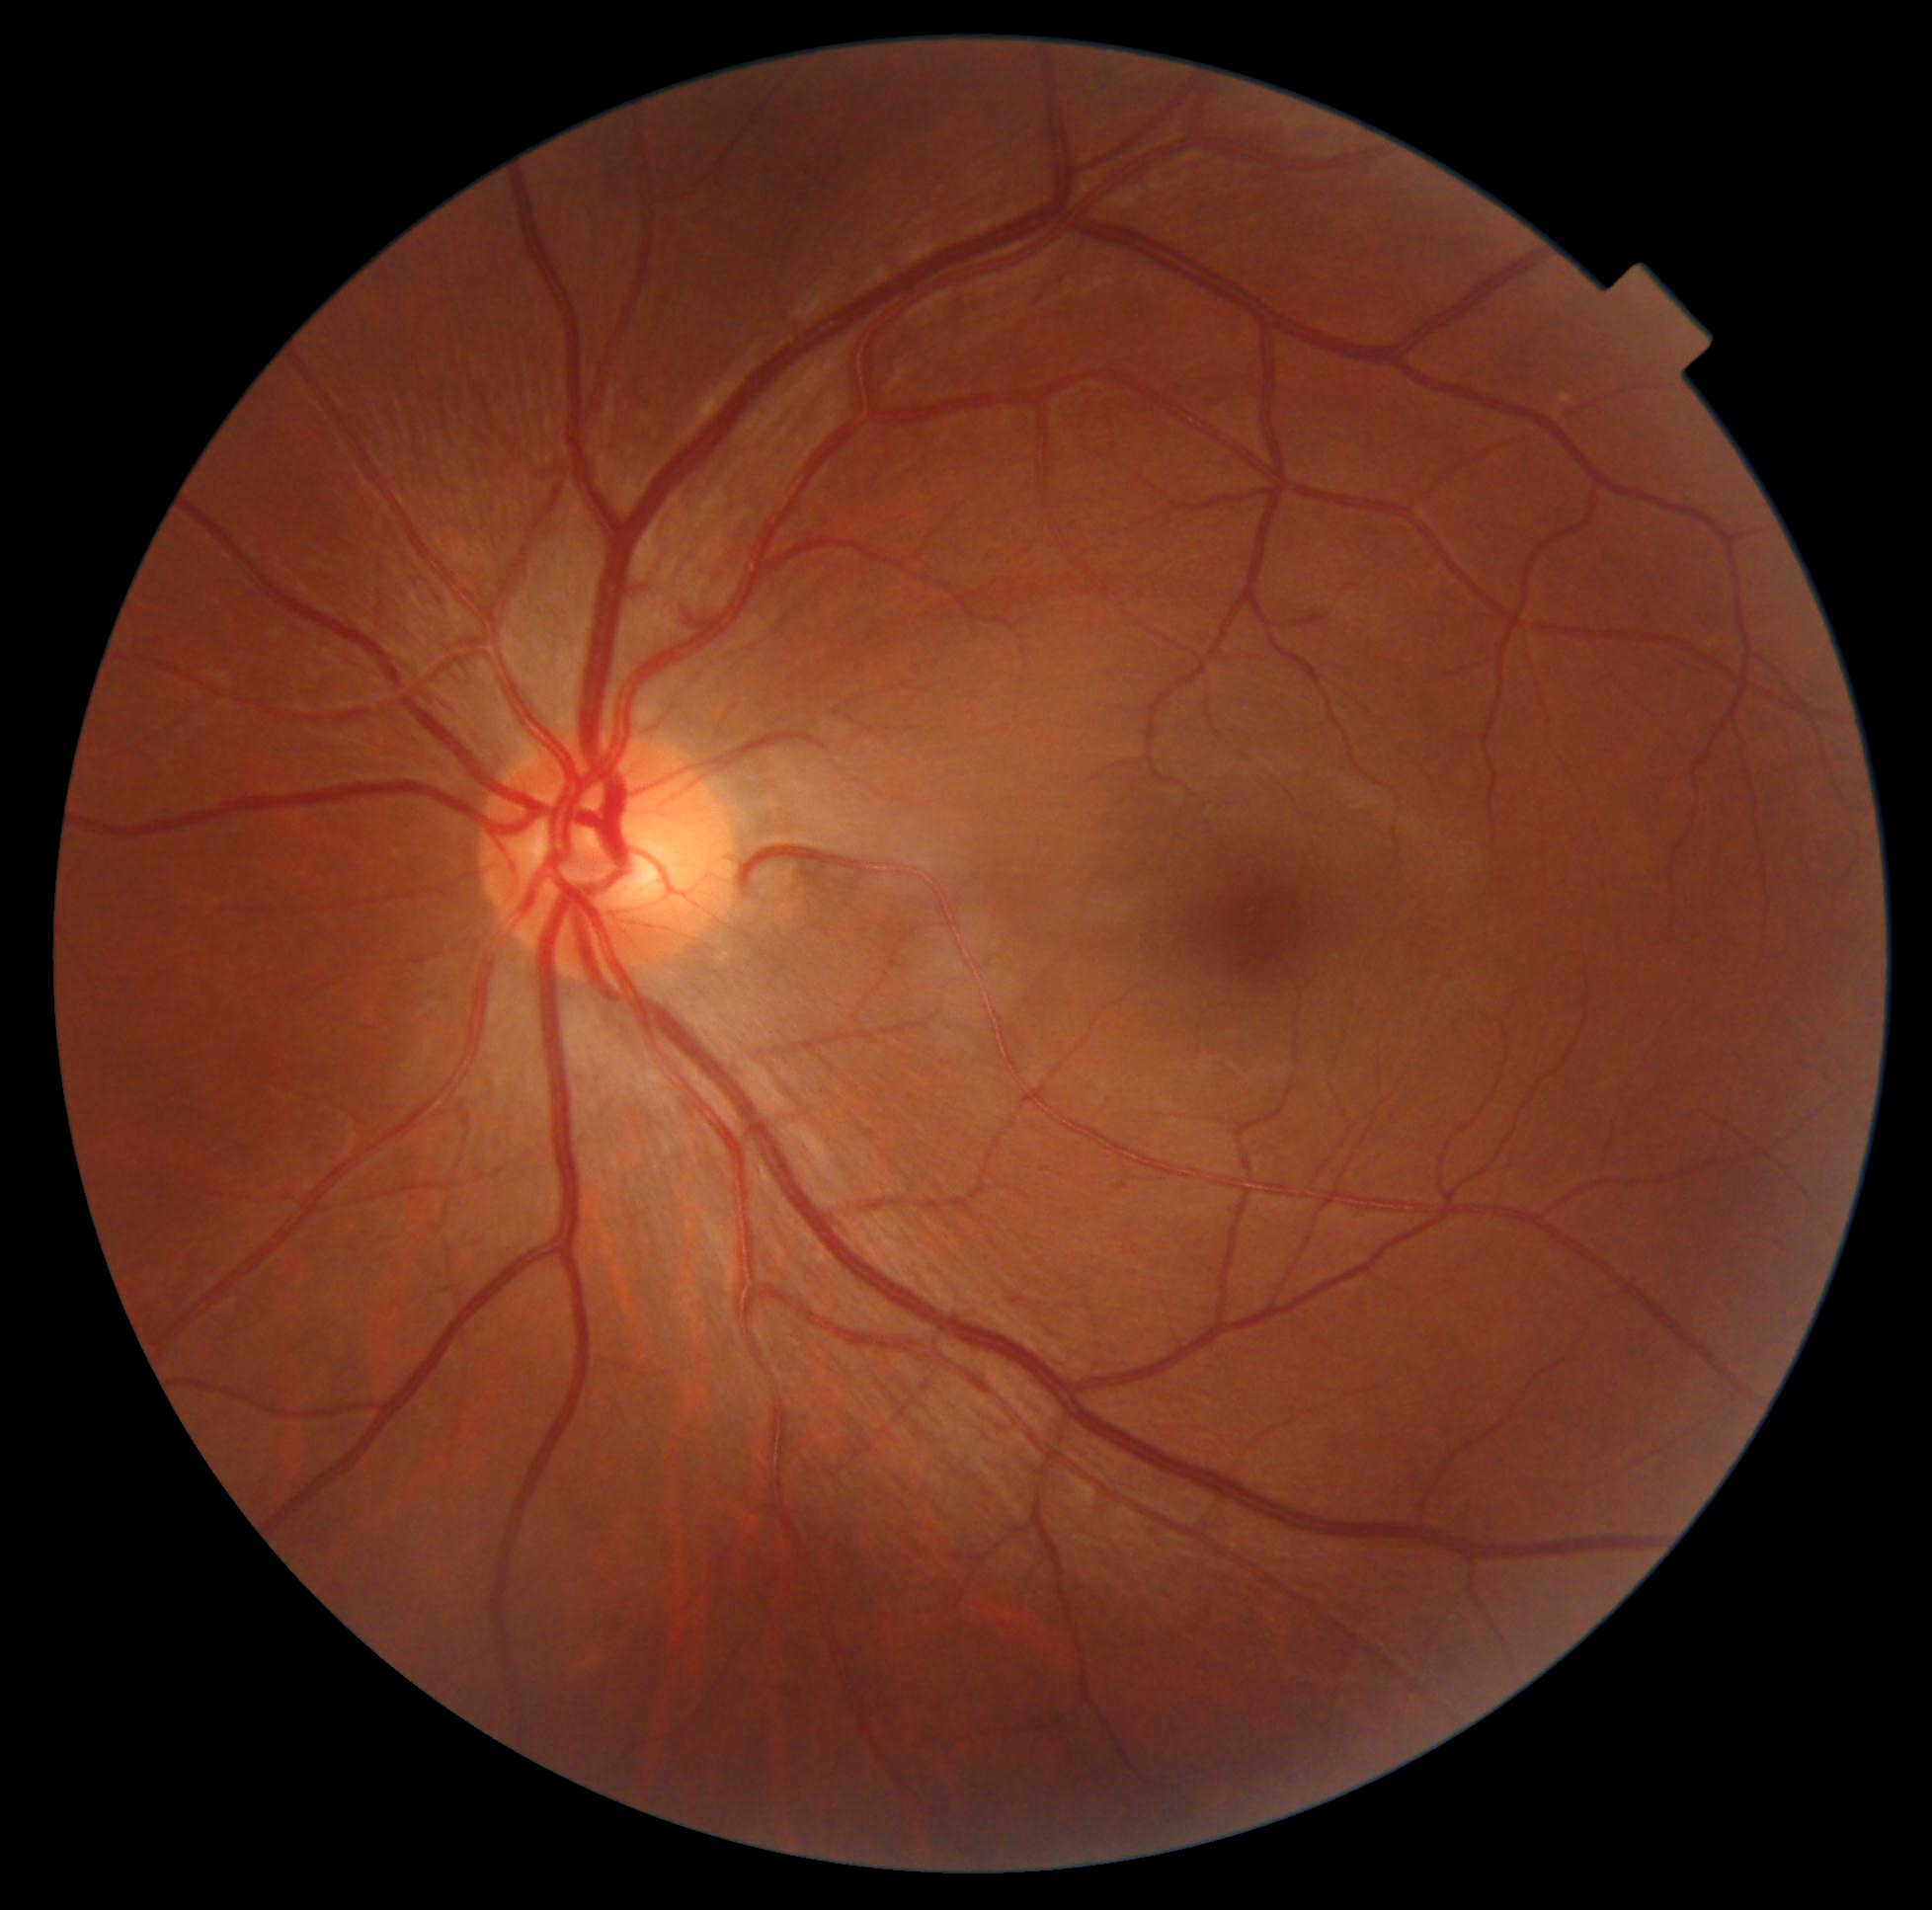 No diabetic retinal disease findings.
DR stage: no apparent retinopathy (grade 0).